2048 by 1536 pixels: 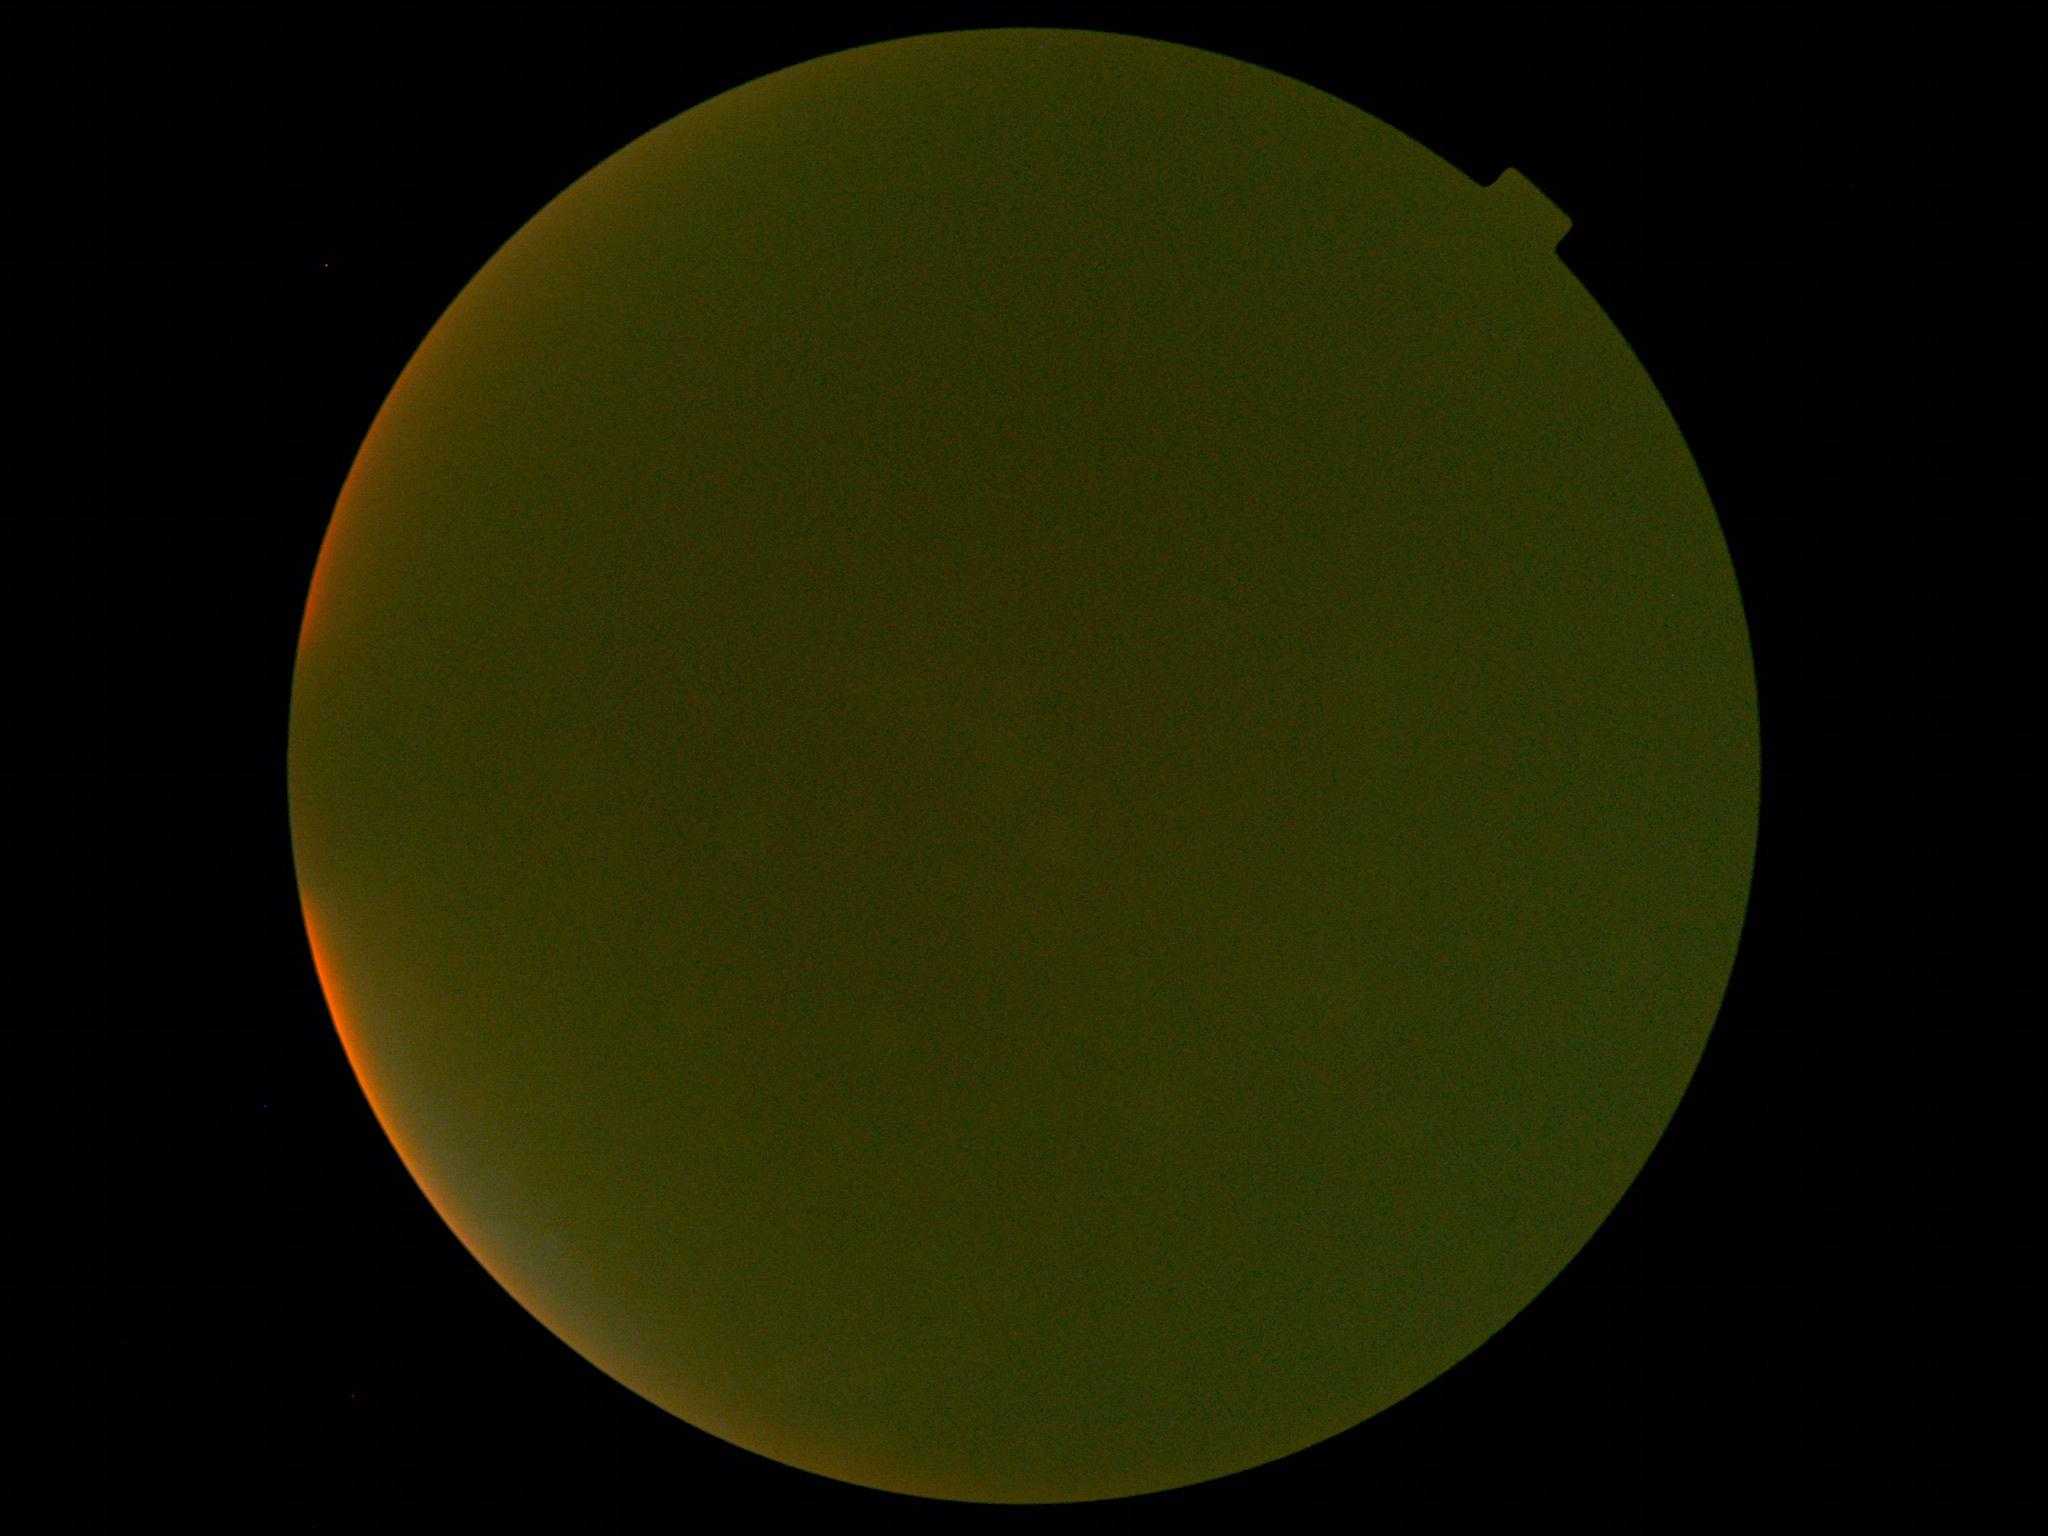 Diabetic retinopathy grade: ungradable.